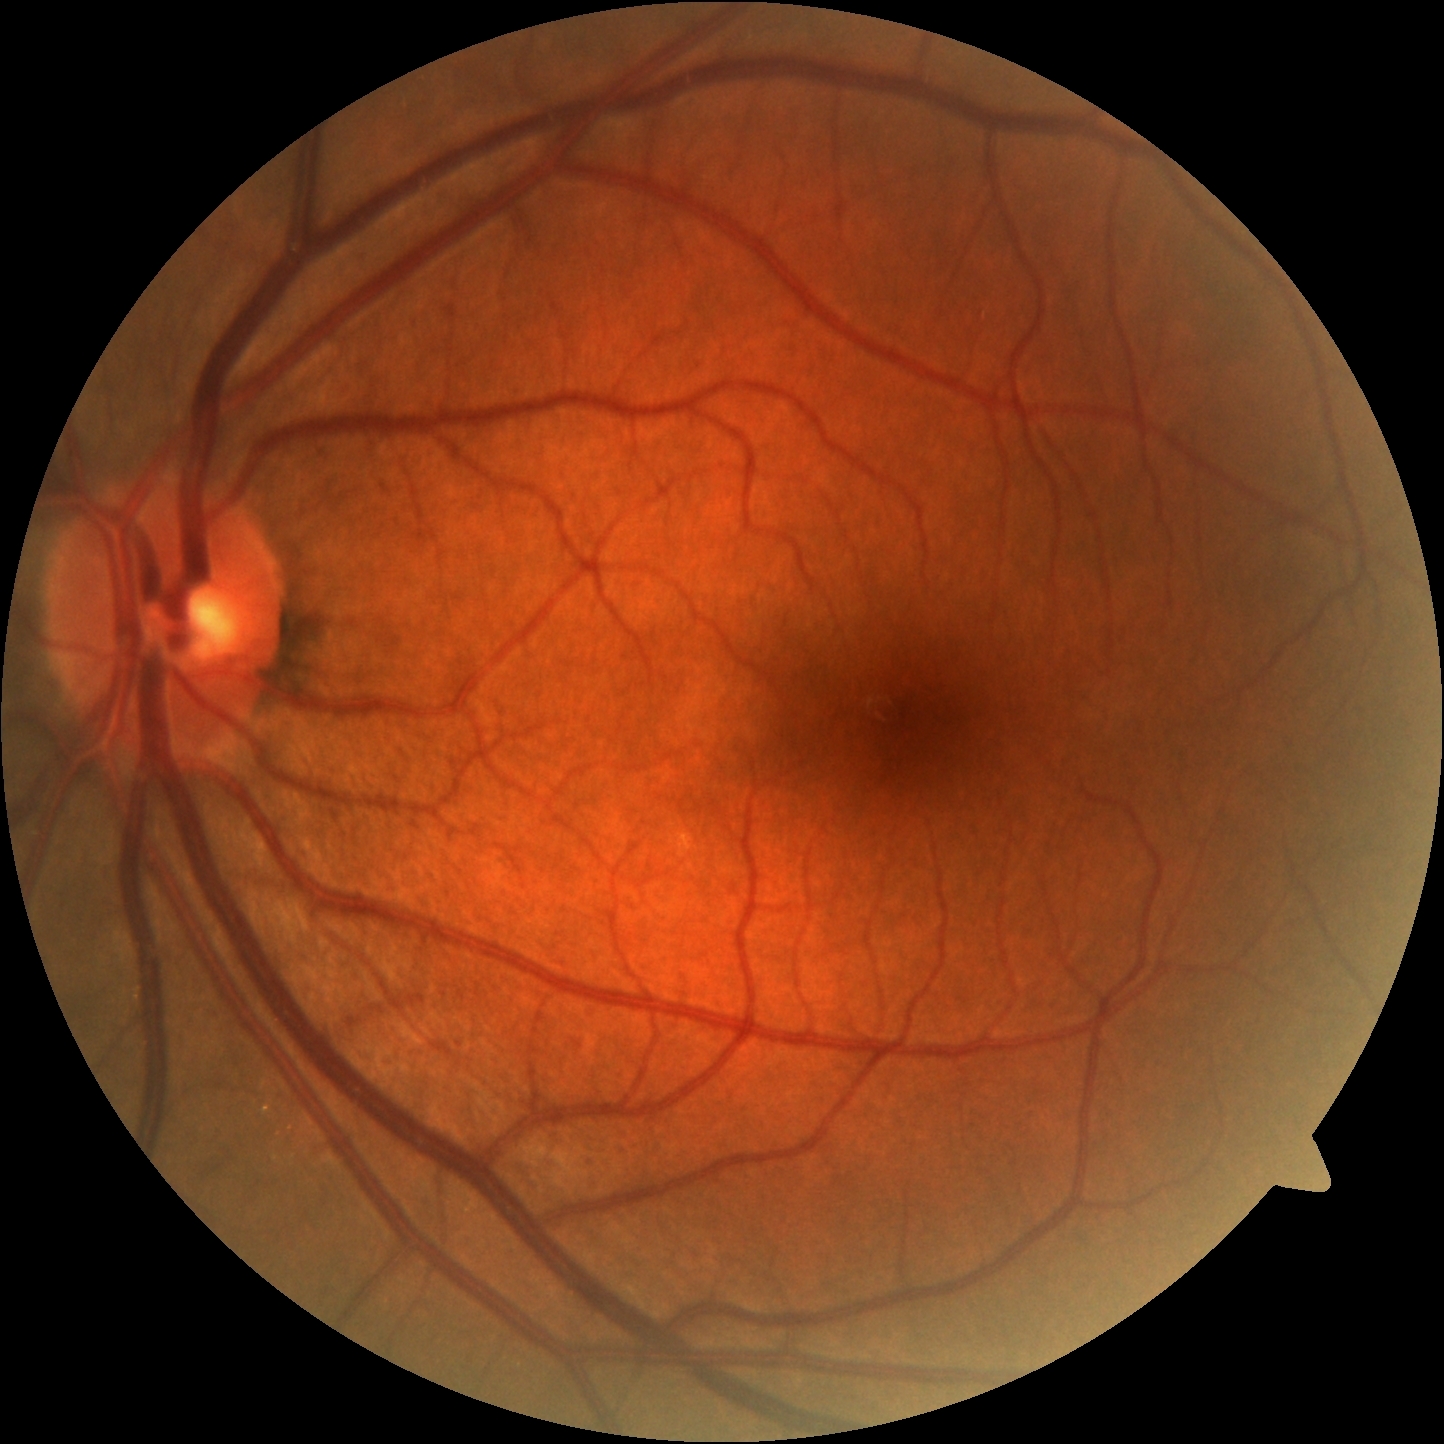 DR grade: 0.